45° field of view.
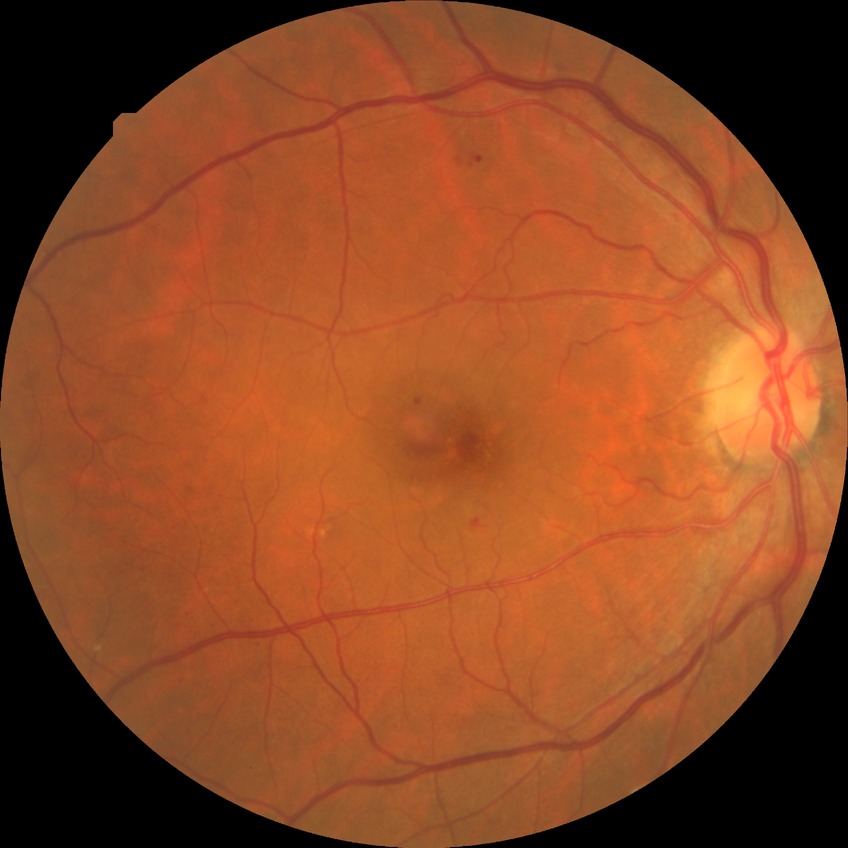
- DR class — non-proliferative diabetic retinopathy
- modified Davis classification — simple diabetic retinopathy